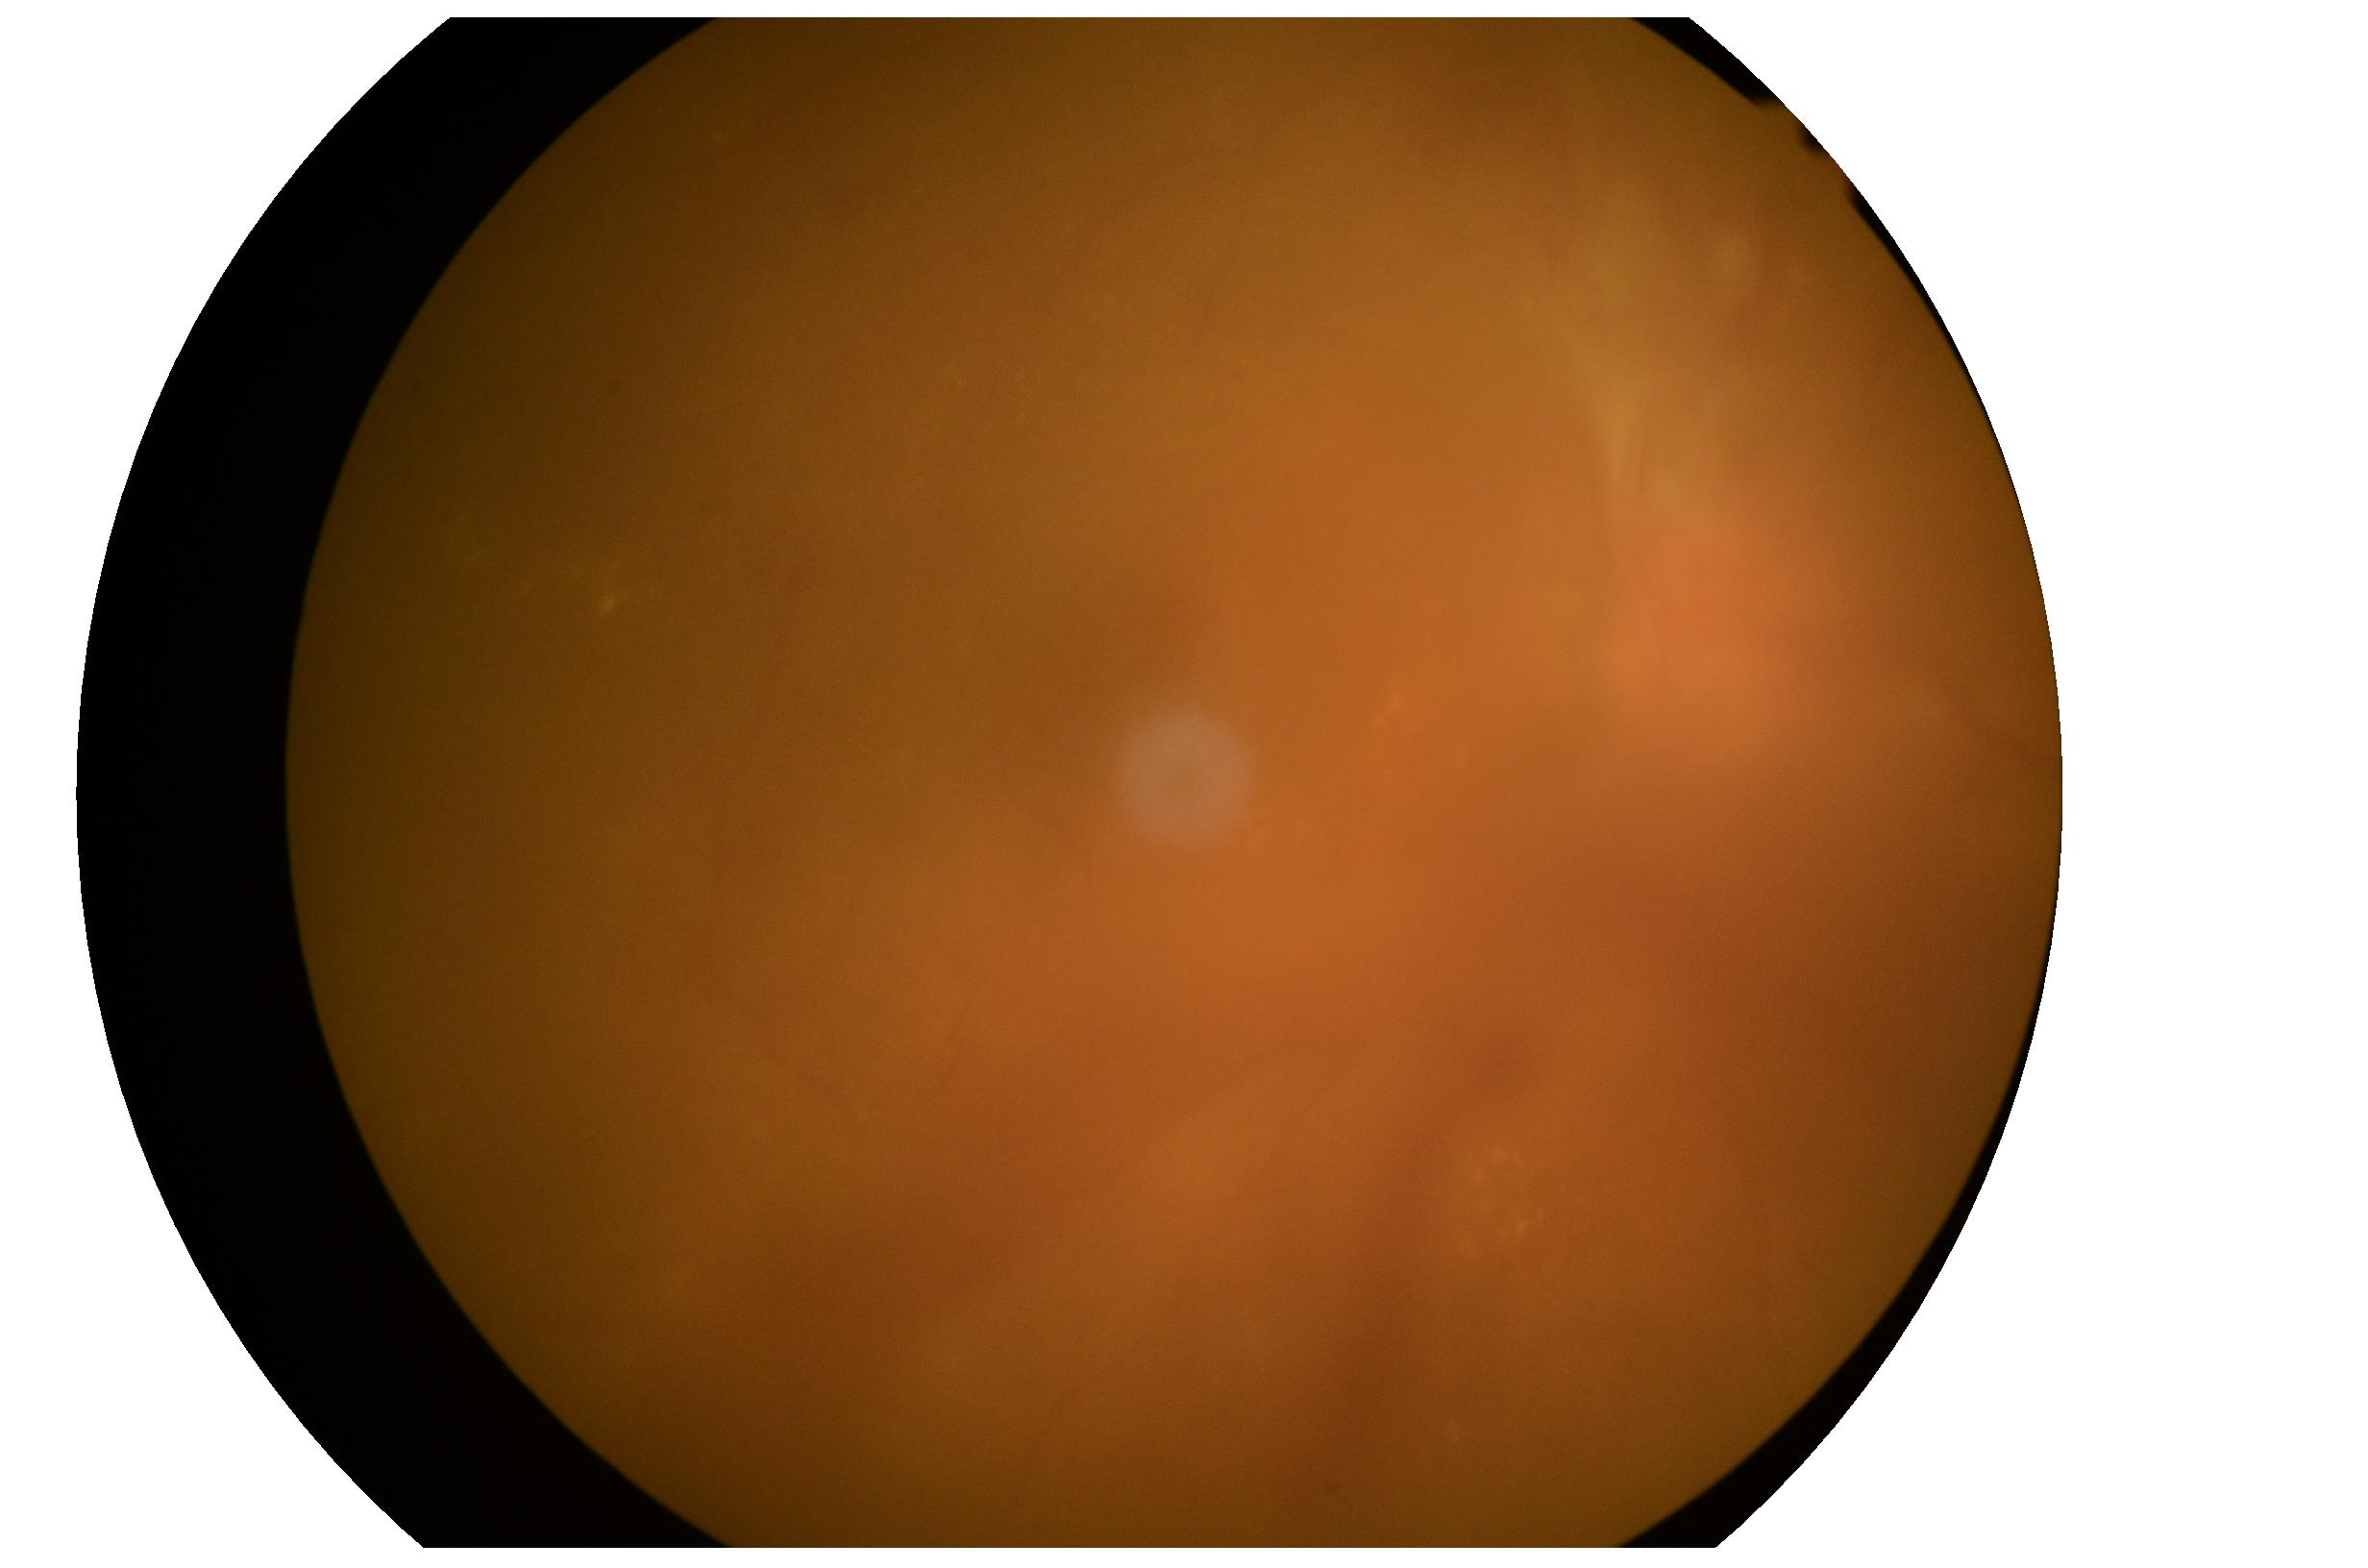
* DR — PDR (grade 4)